Infant wide-field retinal image. 130° field of view (Clarity RetCam 3) — 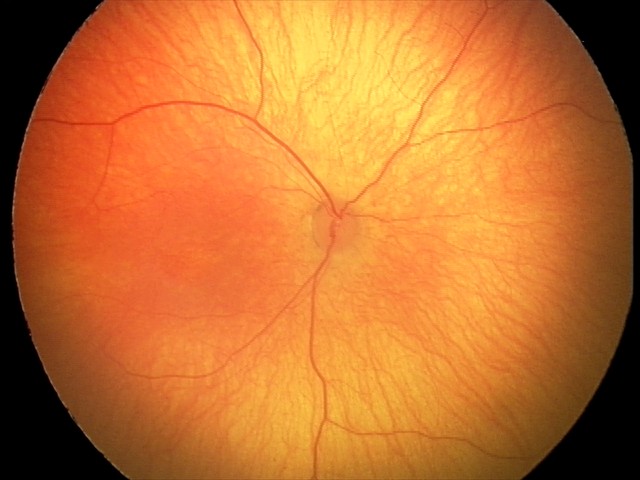 No retinal pathology identified on screening.